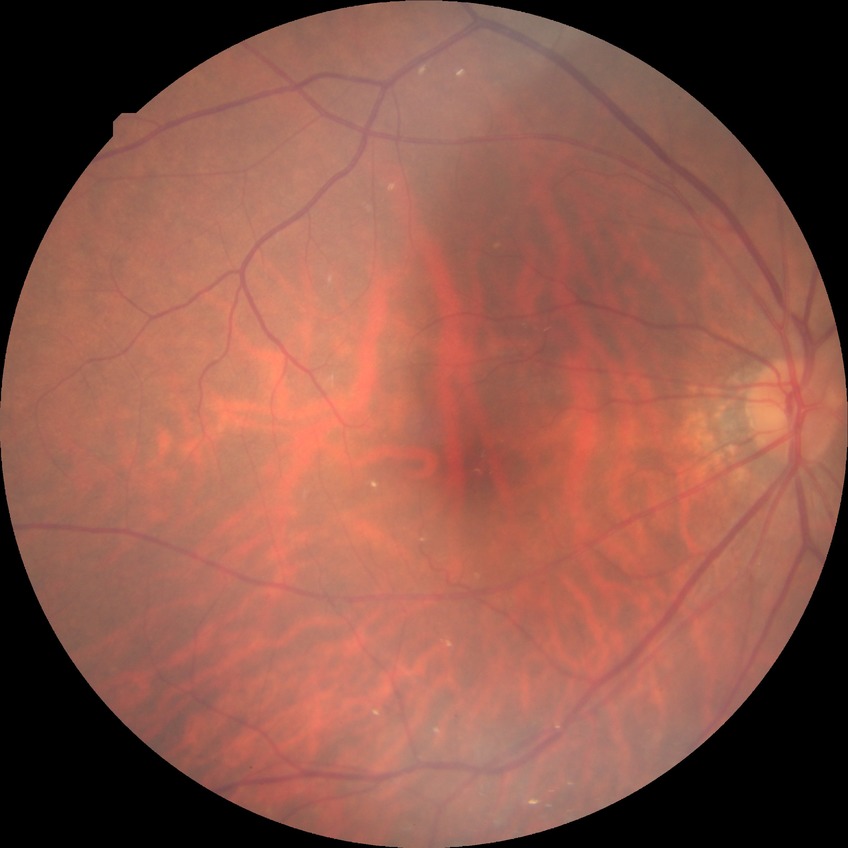

Diabetic retinopathy (DR) is no diabetic retinopathy (NDR).